Wide-field contact fundus photograph of an infant — 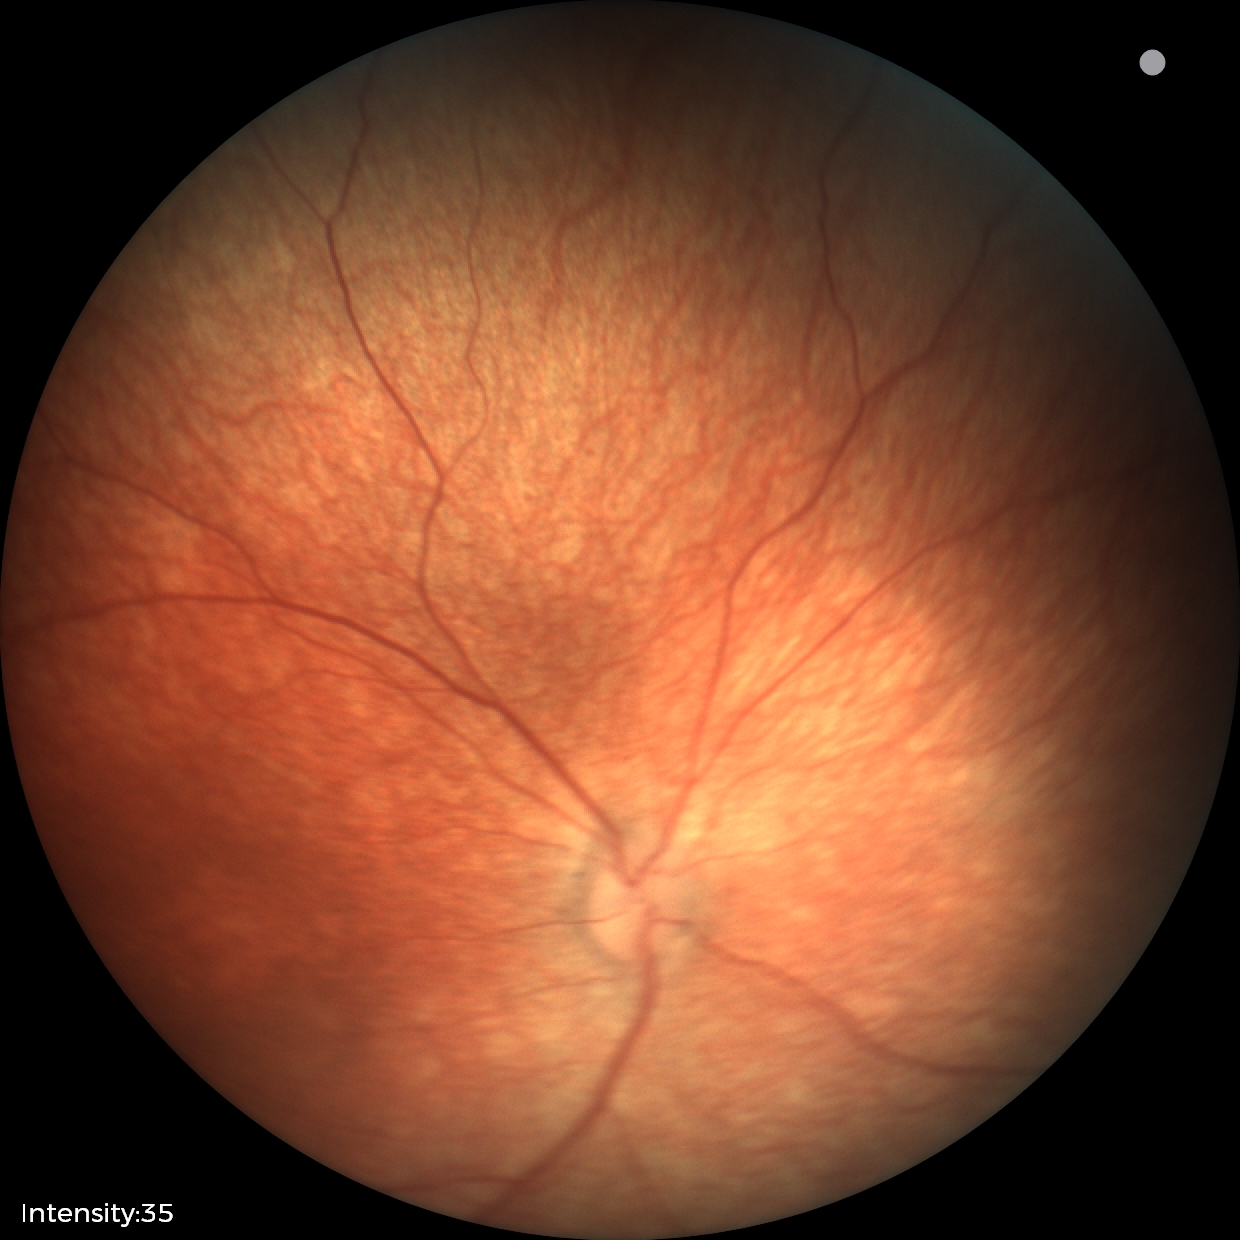

Screening examination diagnosed as physiological.